Nonmydriatic.
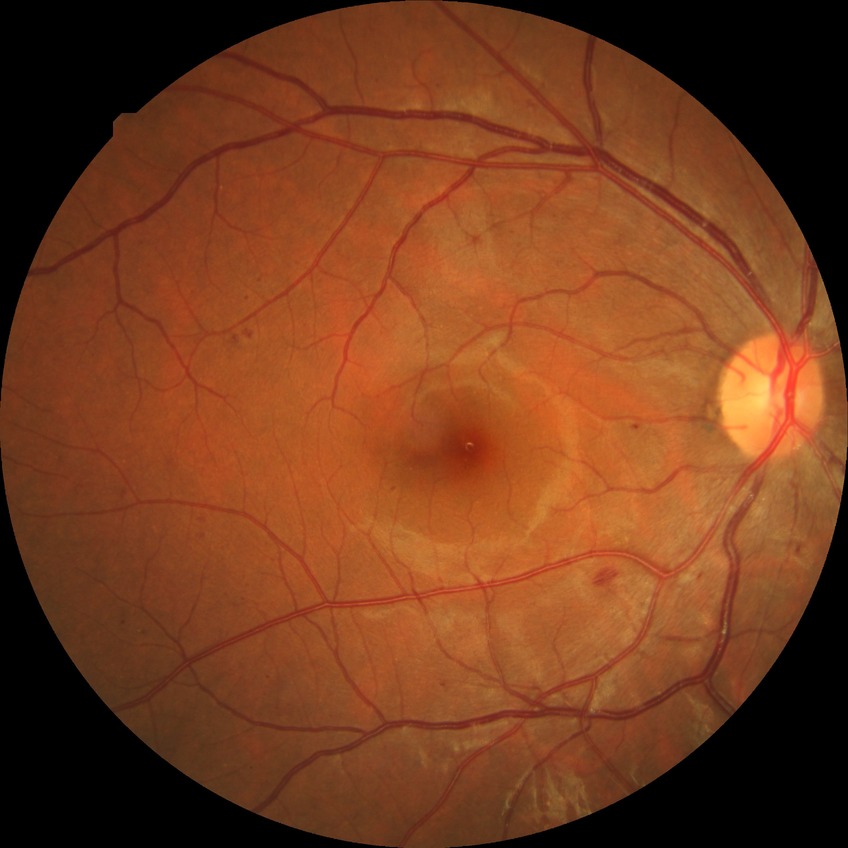

Diabetic retinopathy (DR): simple diabetic retinopathy (SDR).